1924x1556 · UWF retinal mosaic:
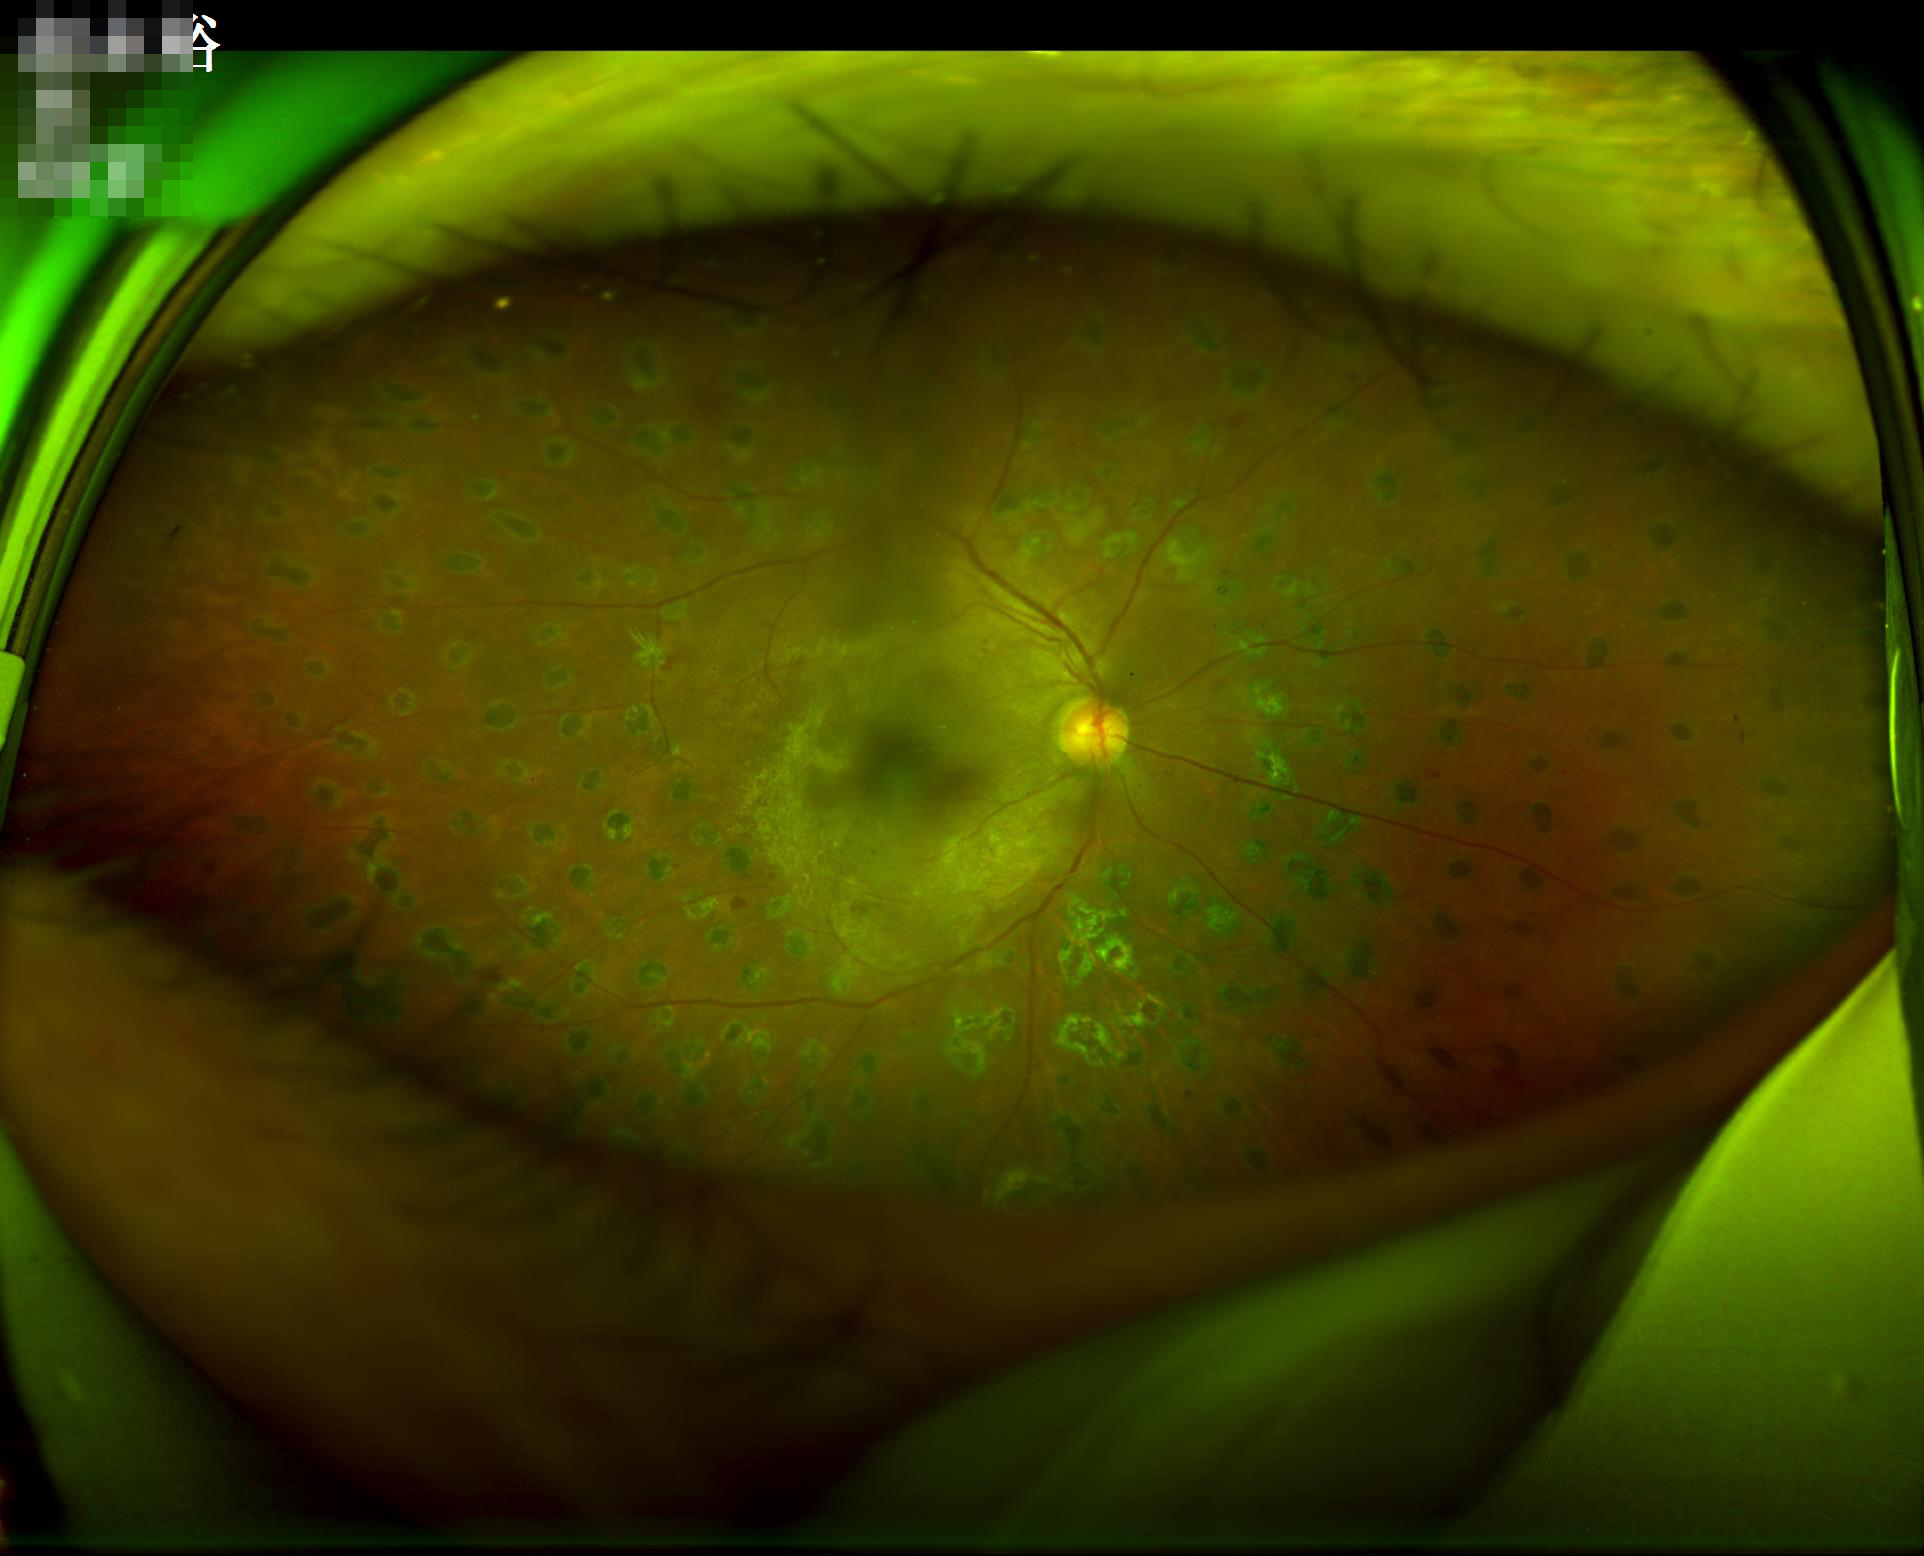 No over- or under-exposure. Image quality is adequate for diagnostic use. The image is blurry.